2352 x 1568 pixels.
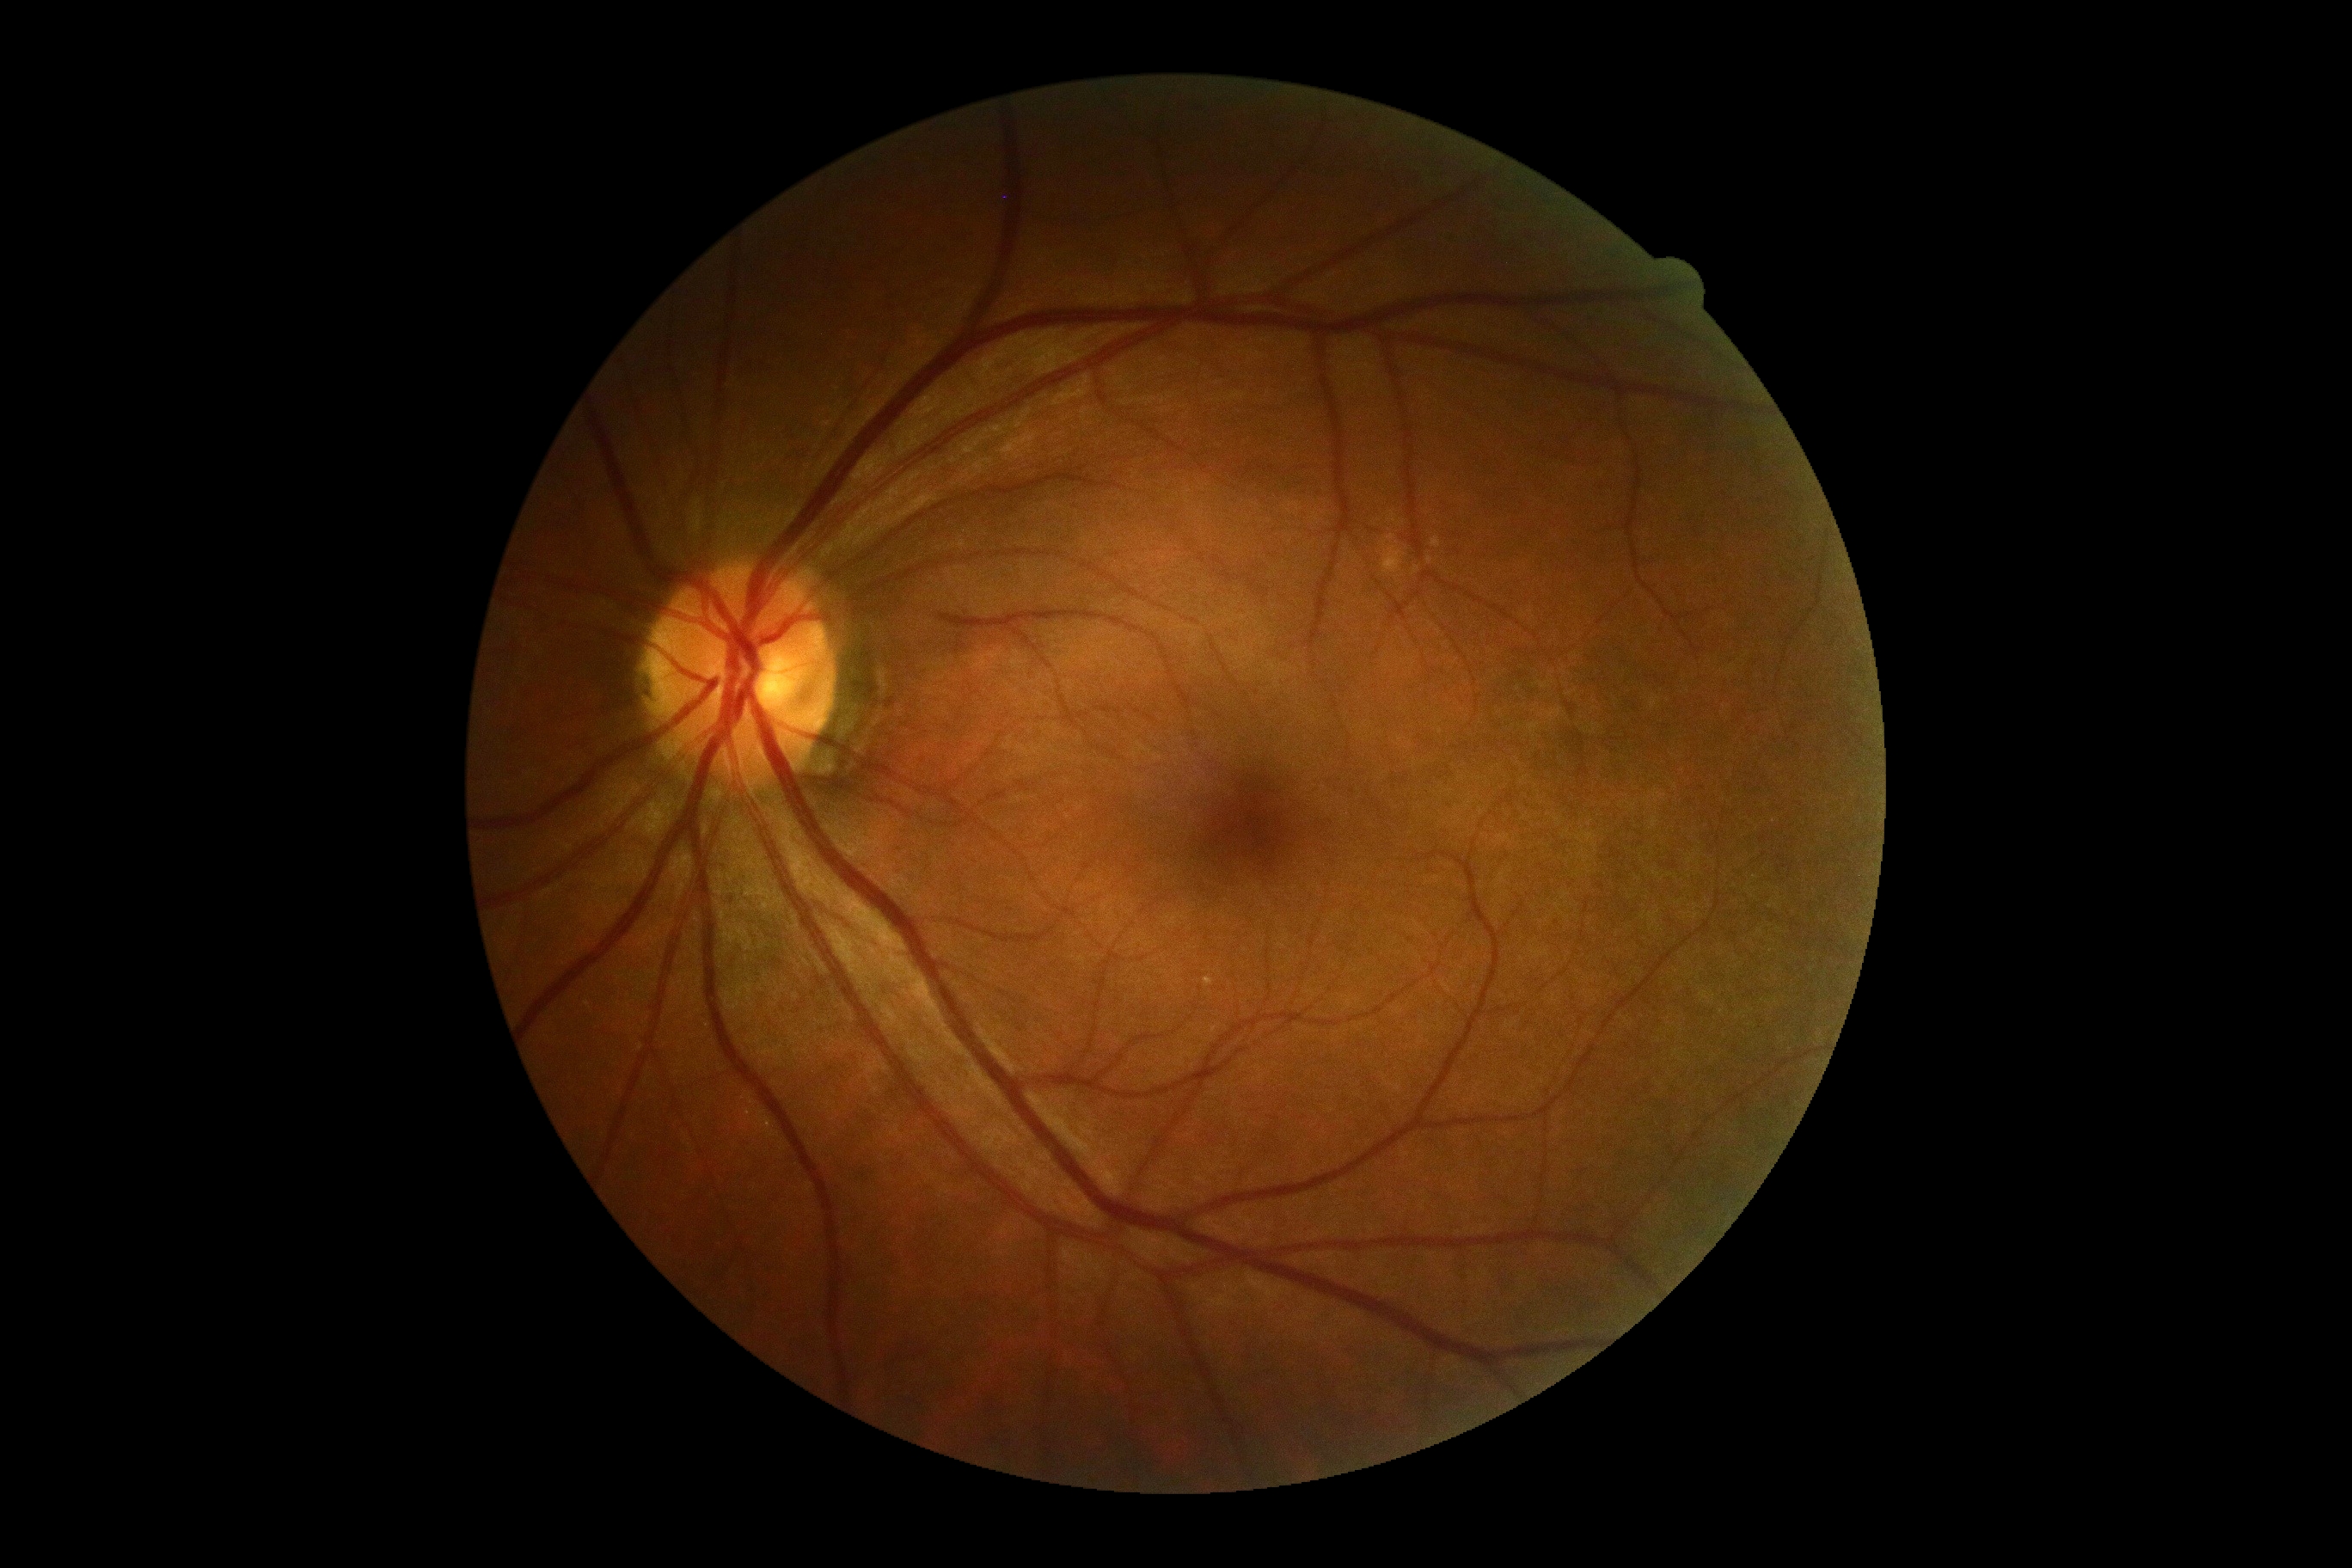
DR severity: no apparent retinopathy (grade 0) — no visible signs of diabetic retinopathy.